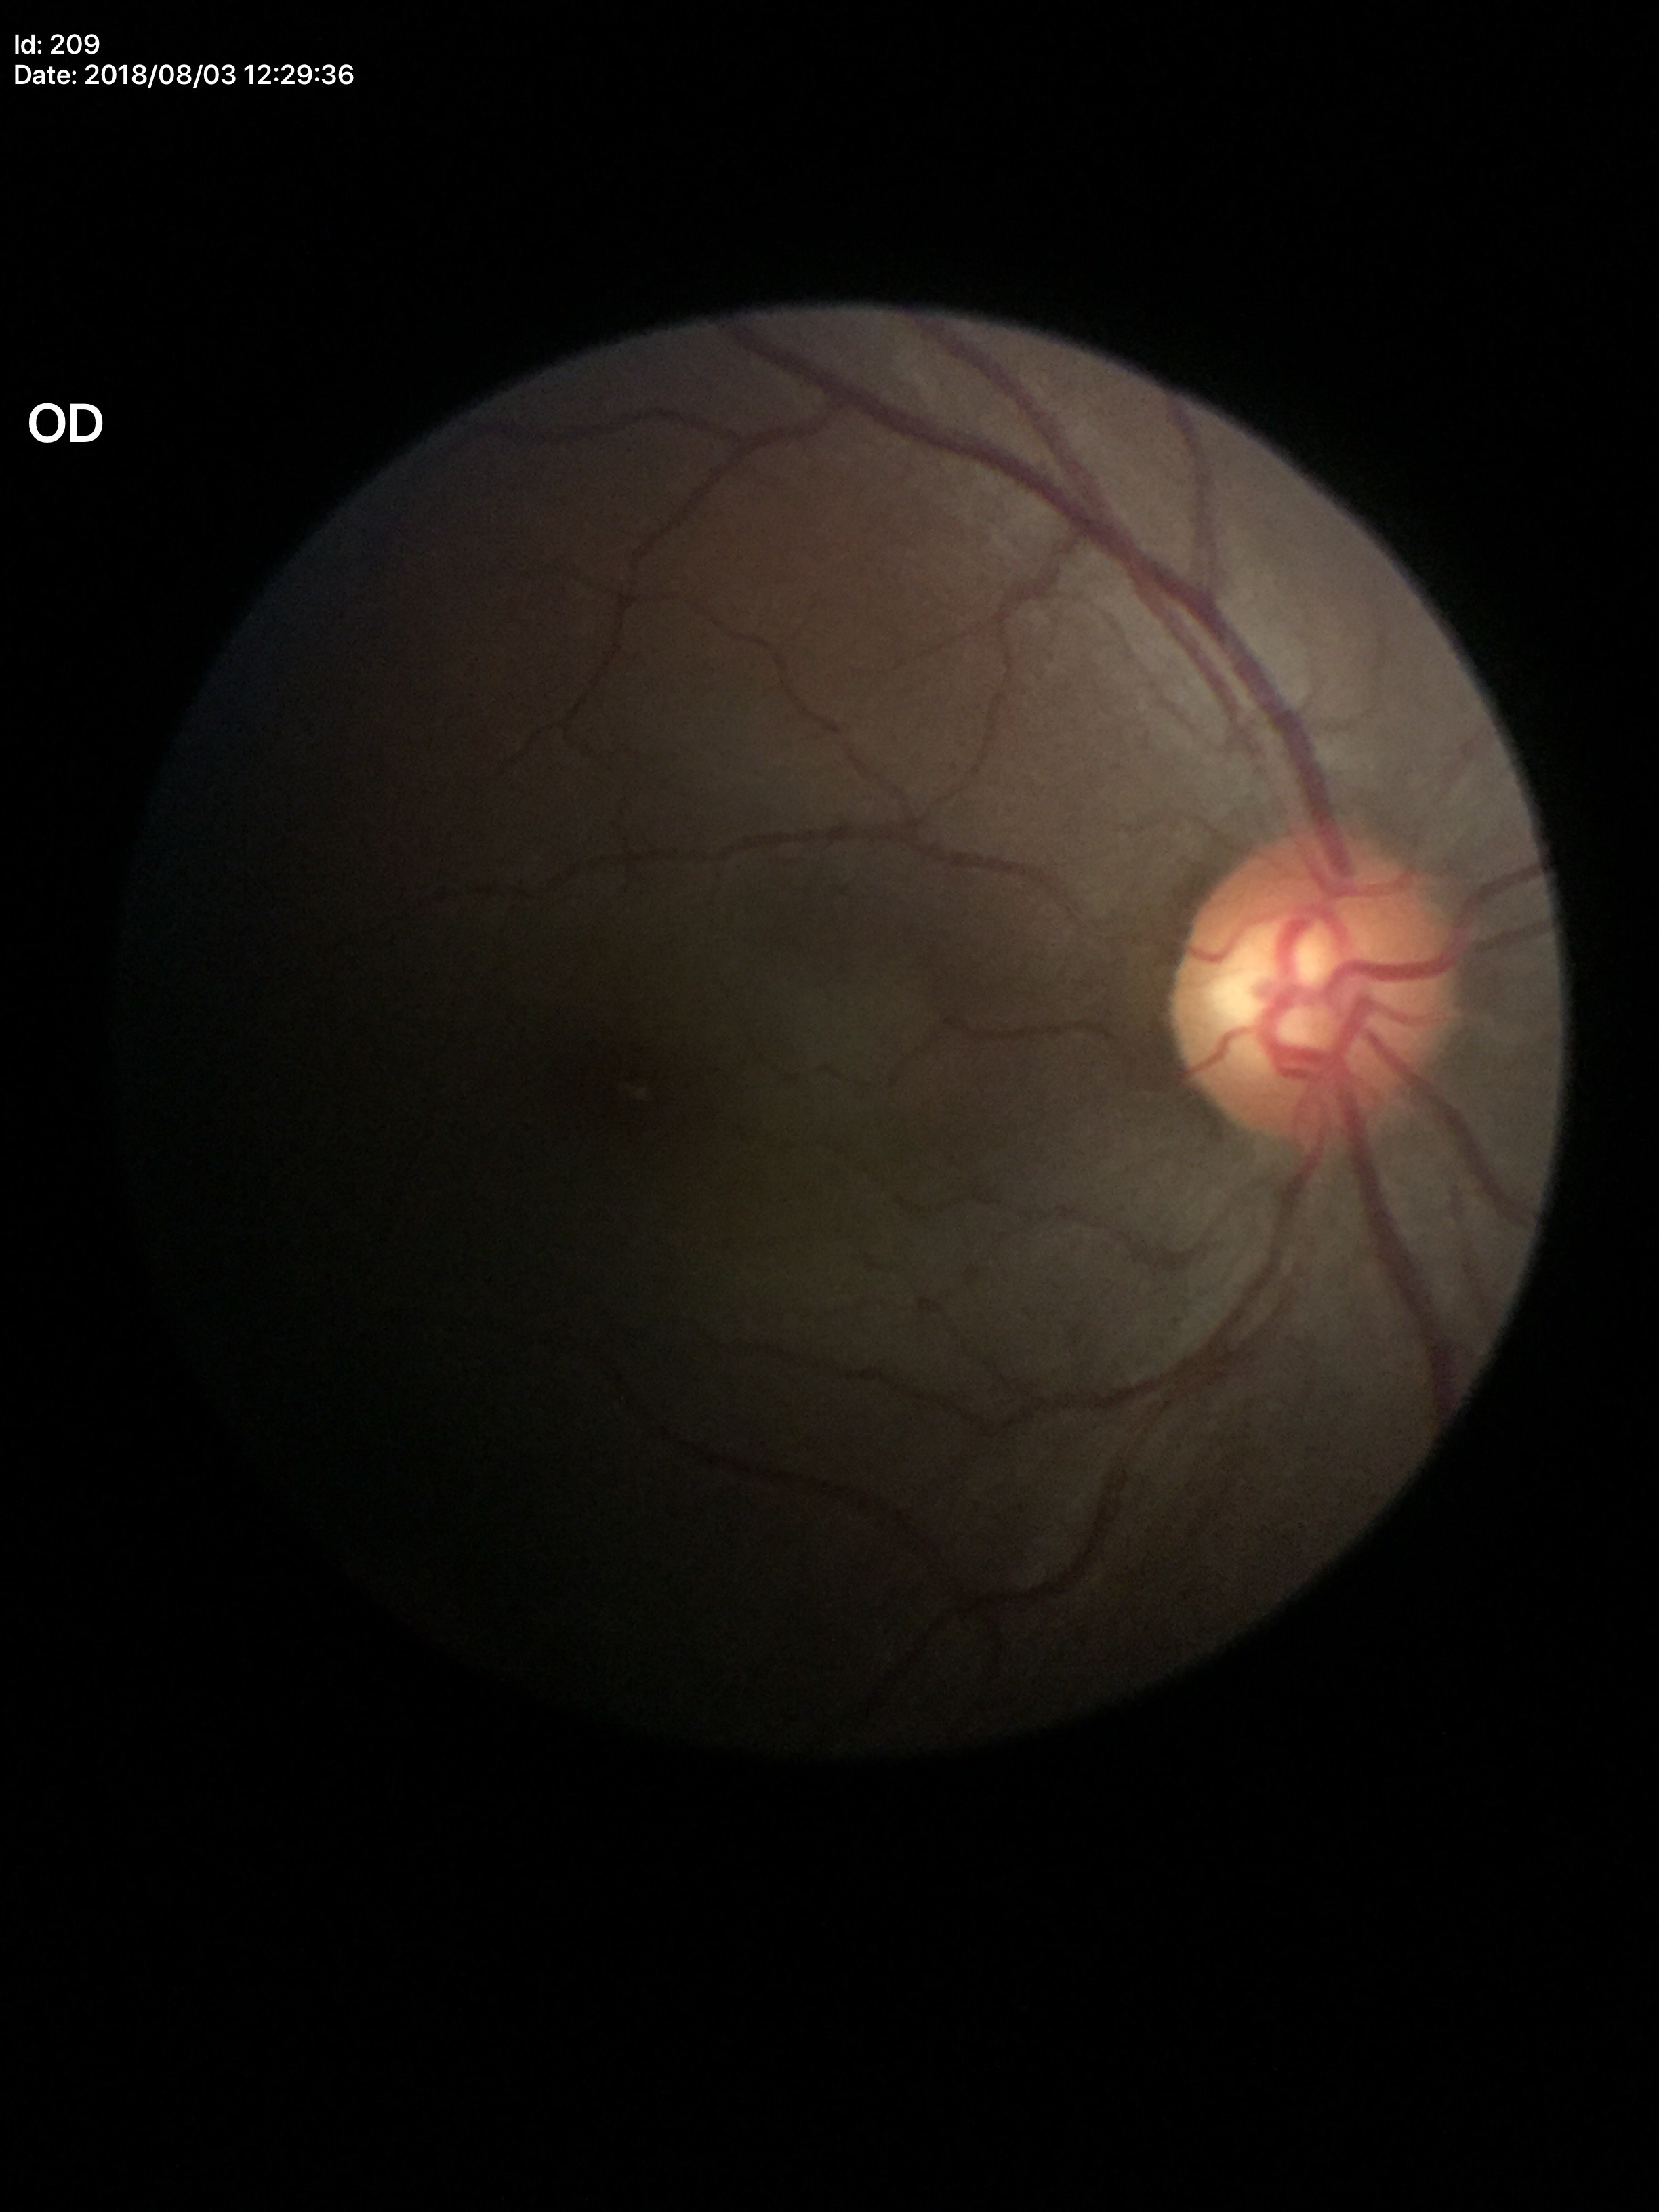

Glaucoma decision = not suspect (unanimous normal call), VCDR = 0.53, HCDR = 0.58.